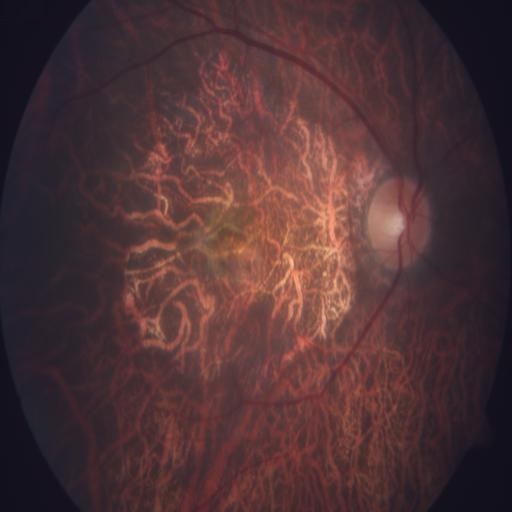
Demonstrates myopia.